130° field of view (Clarity RetCam 3) · wide-field fundus photograph of an infant:
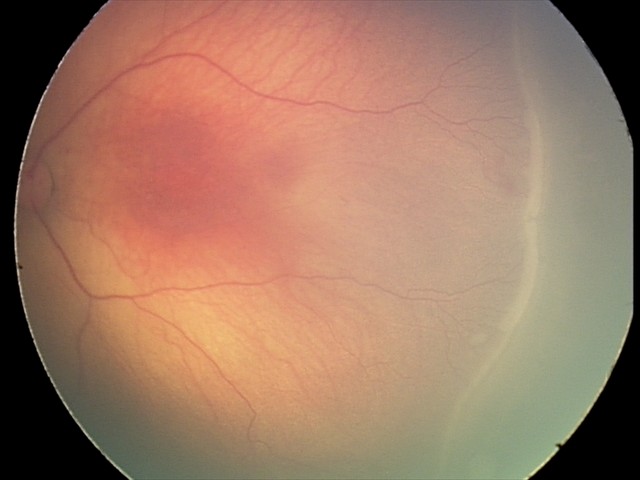

From an examination with diagnosis of ROP stage 2. Without plus disease.